FOV 35° before cropping; color fundus photograph centered on the optic disc; Topcon TRC retinal camera, IMAGEnet capture system.
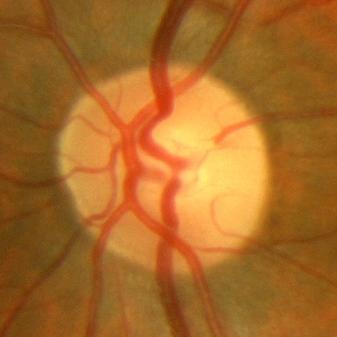
Showing no glaucomatous damage.